Camera: Clarity RetCam 3 (130° FOV) · RetCam wide-field infant fundus image — 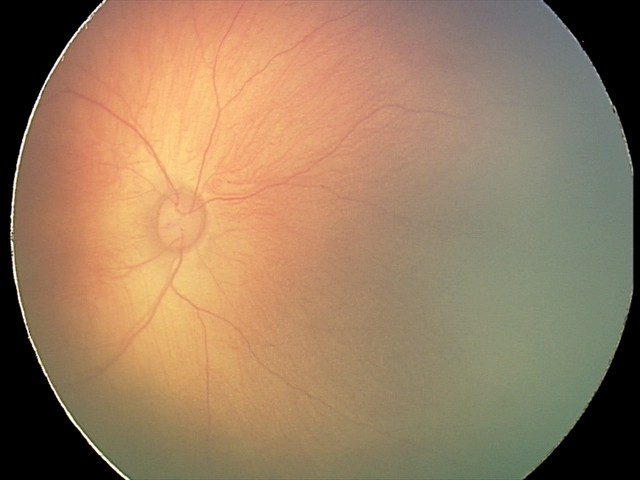 Screening series with retinal hemorrhages.